Phoenix ICON wide-field infant fundus image — 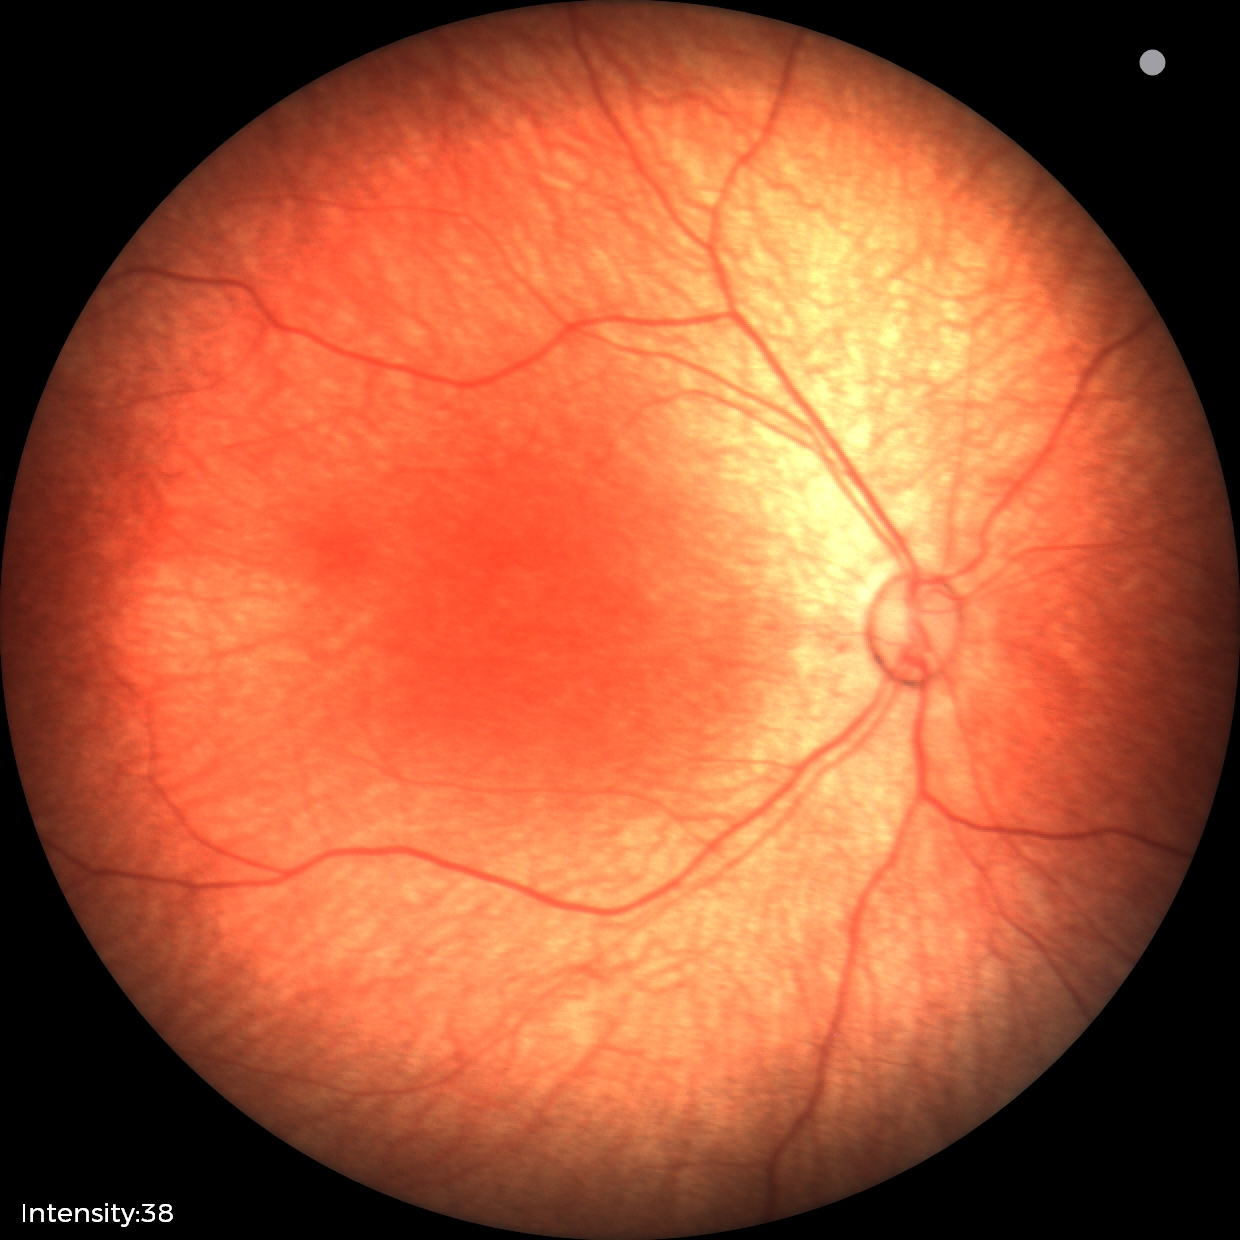

Screening: physiological retinal finding.